Color fundus photograph — 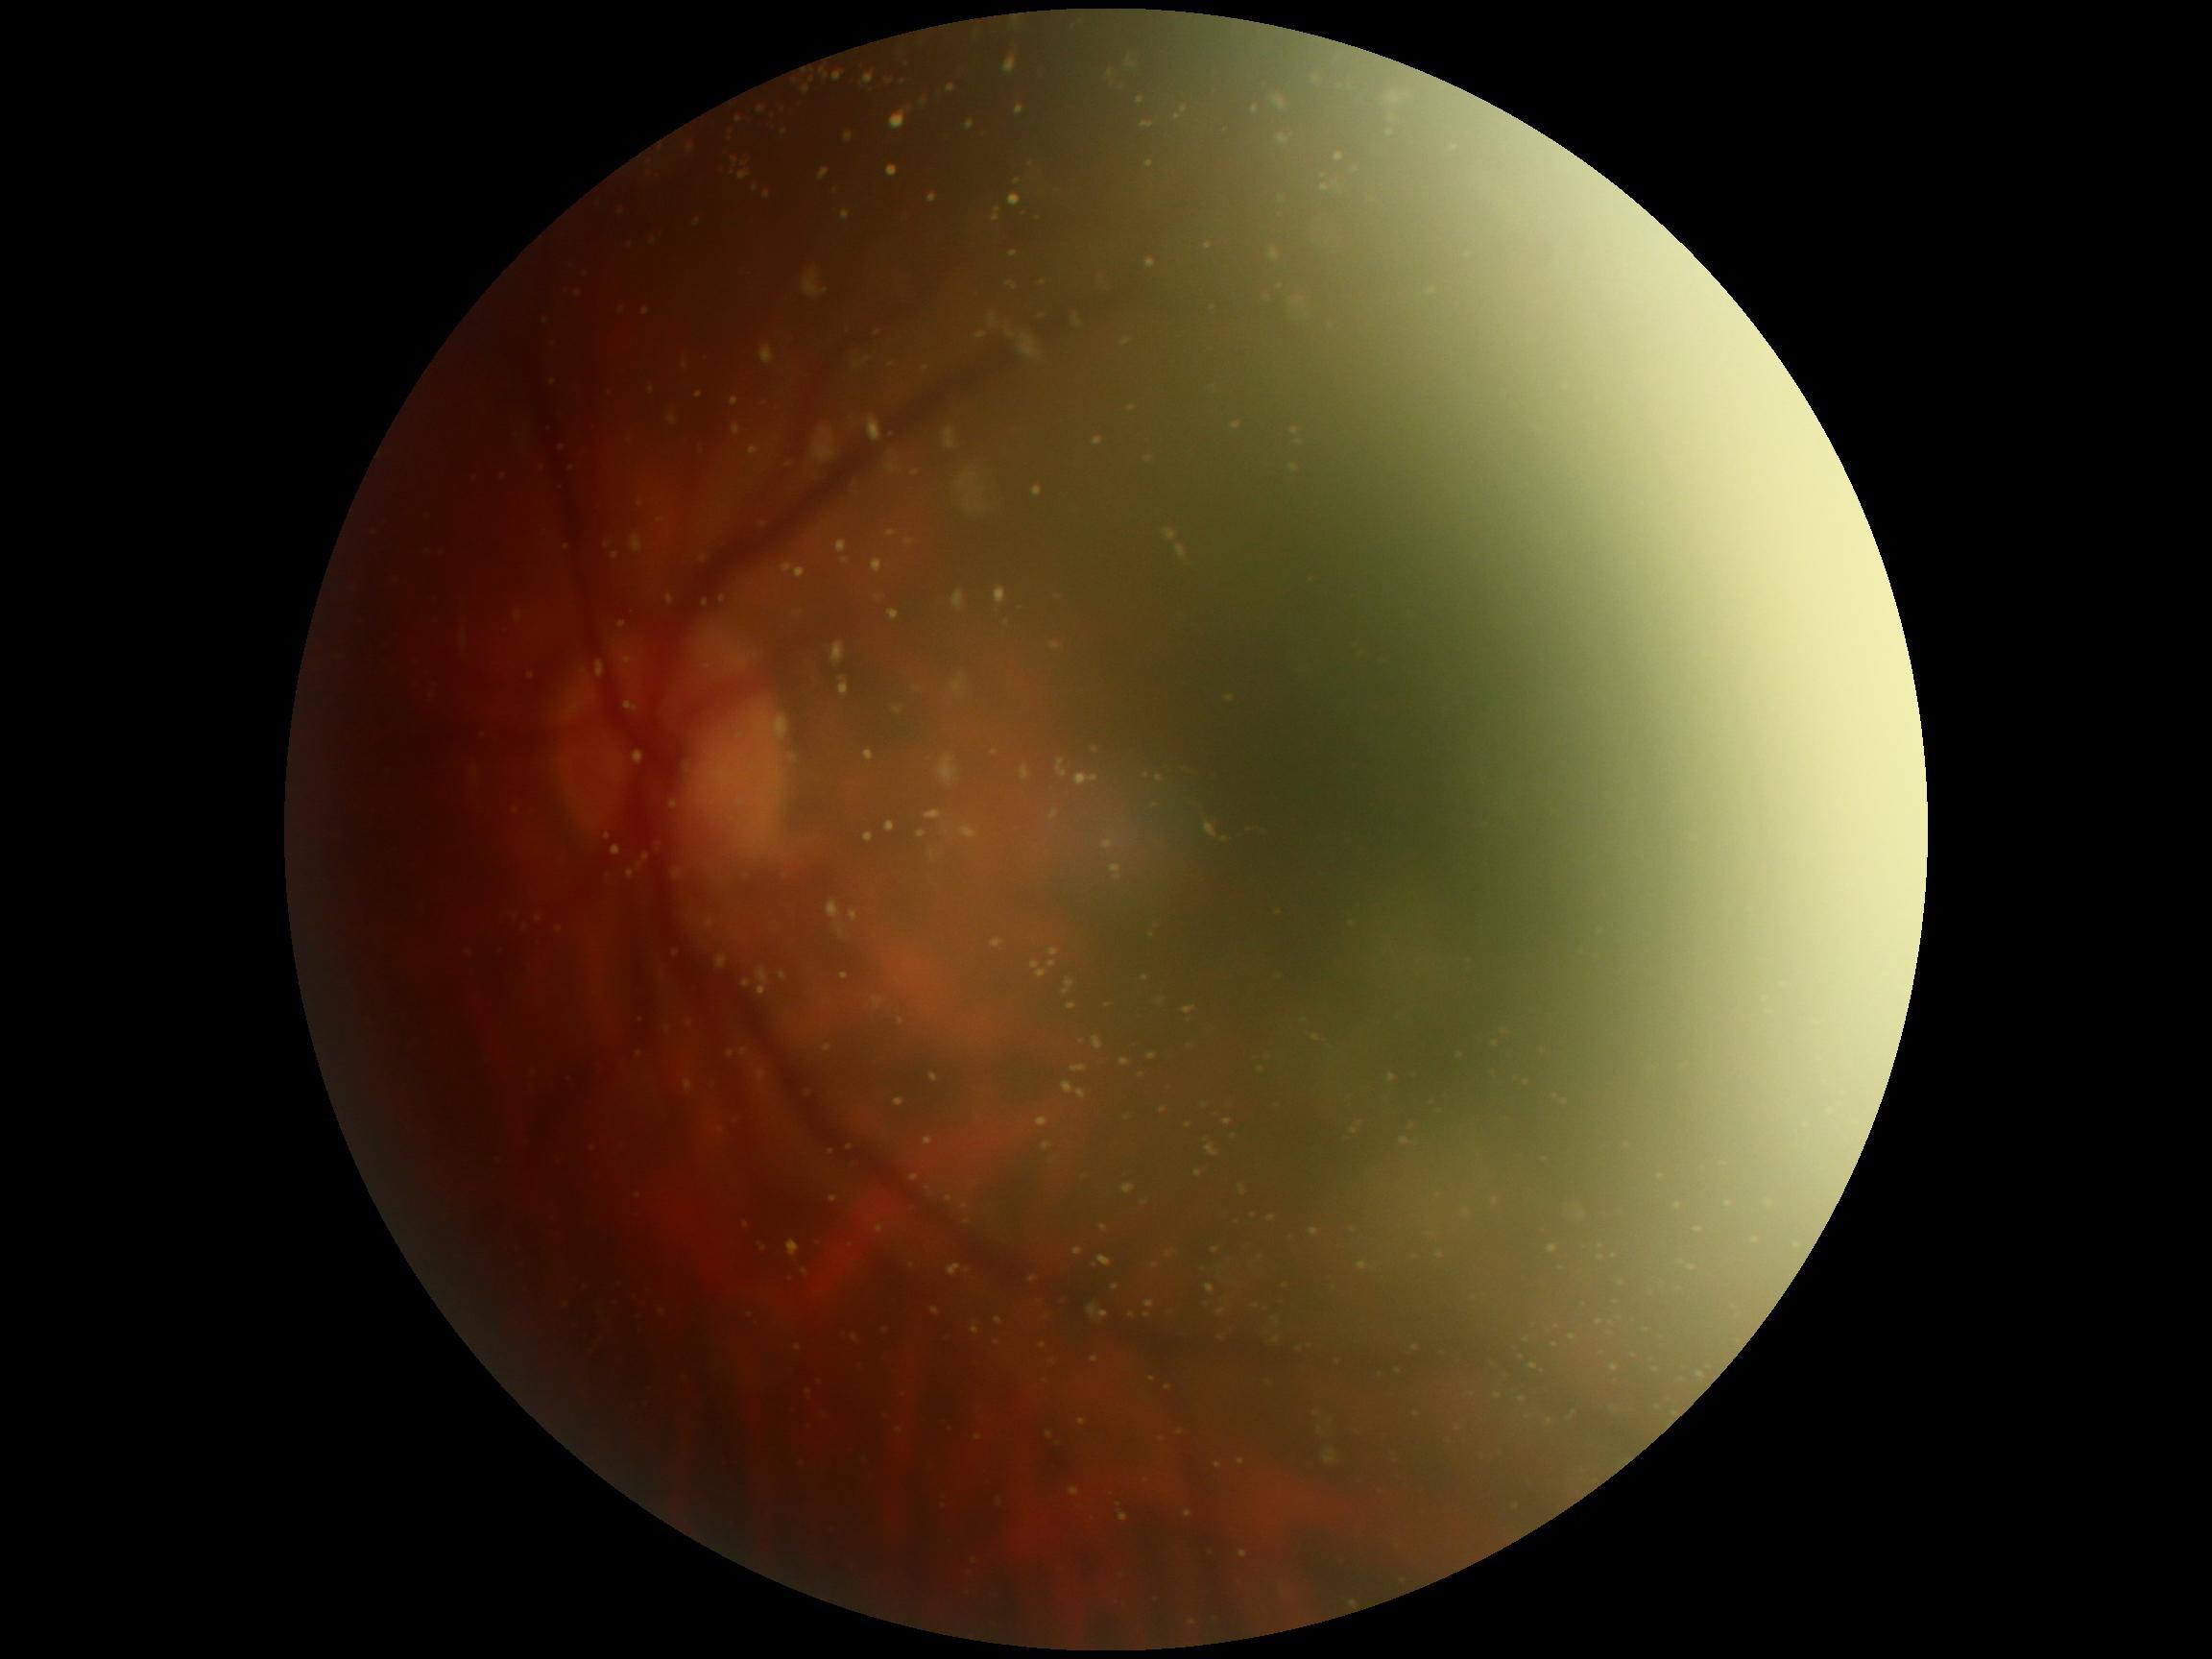

diabetic retinopathy (DR)=ungradable, image quality=below grading threshold.